Remidio FOP fundus camera.
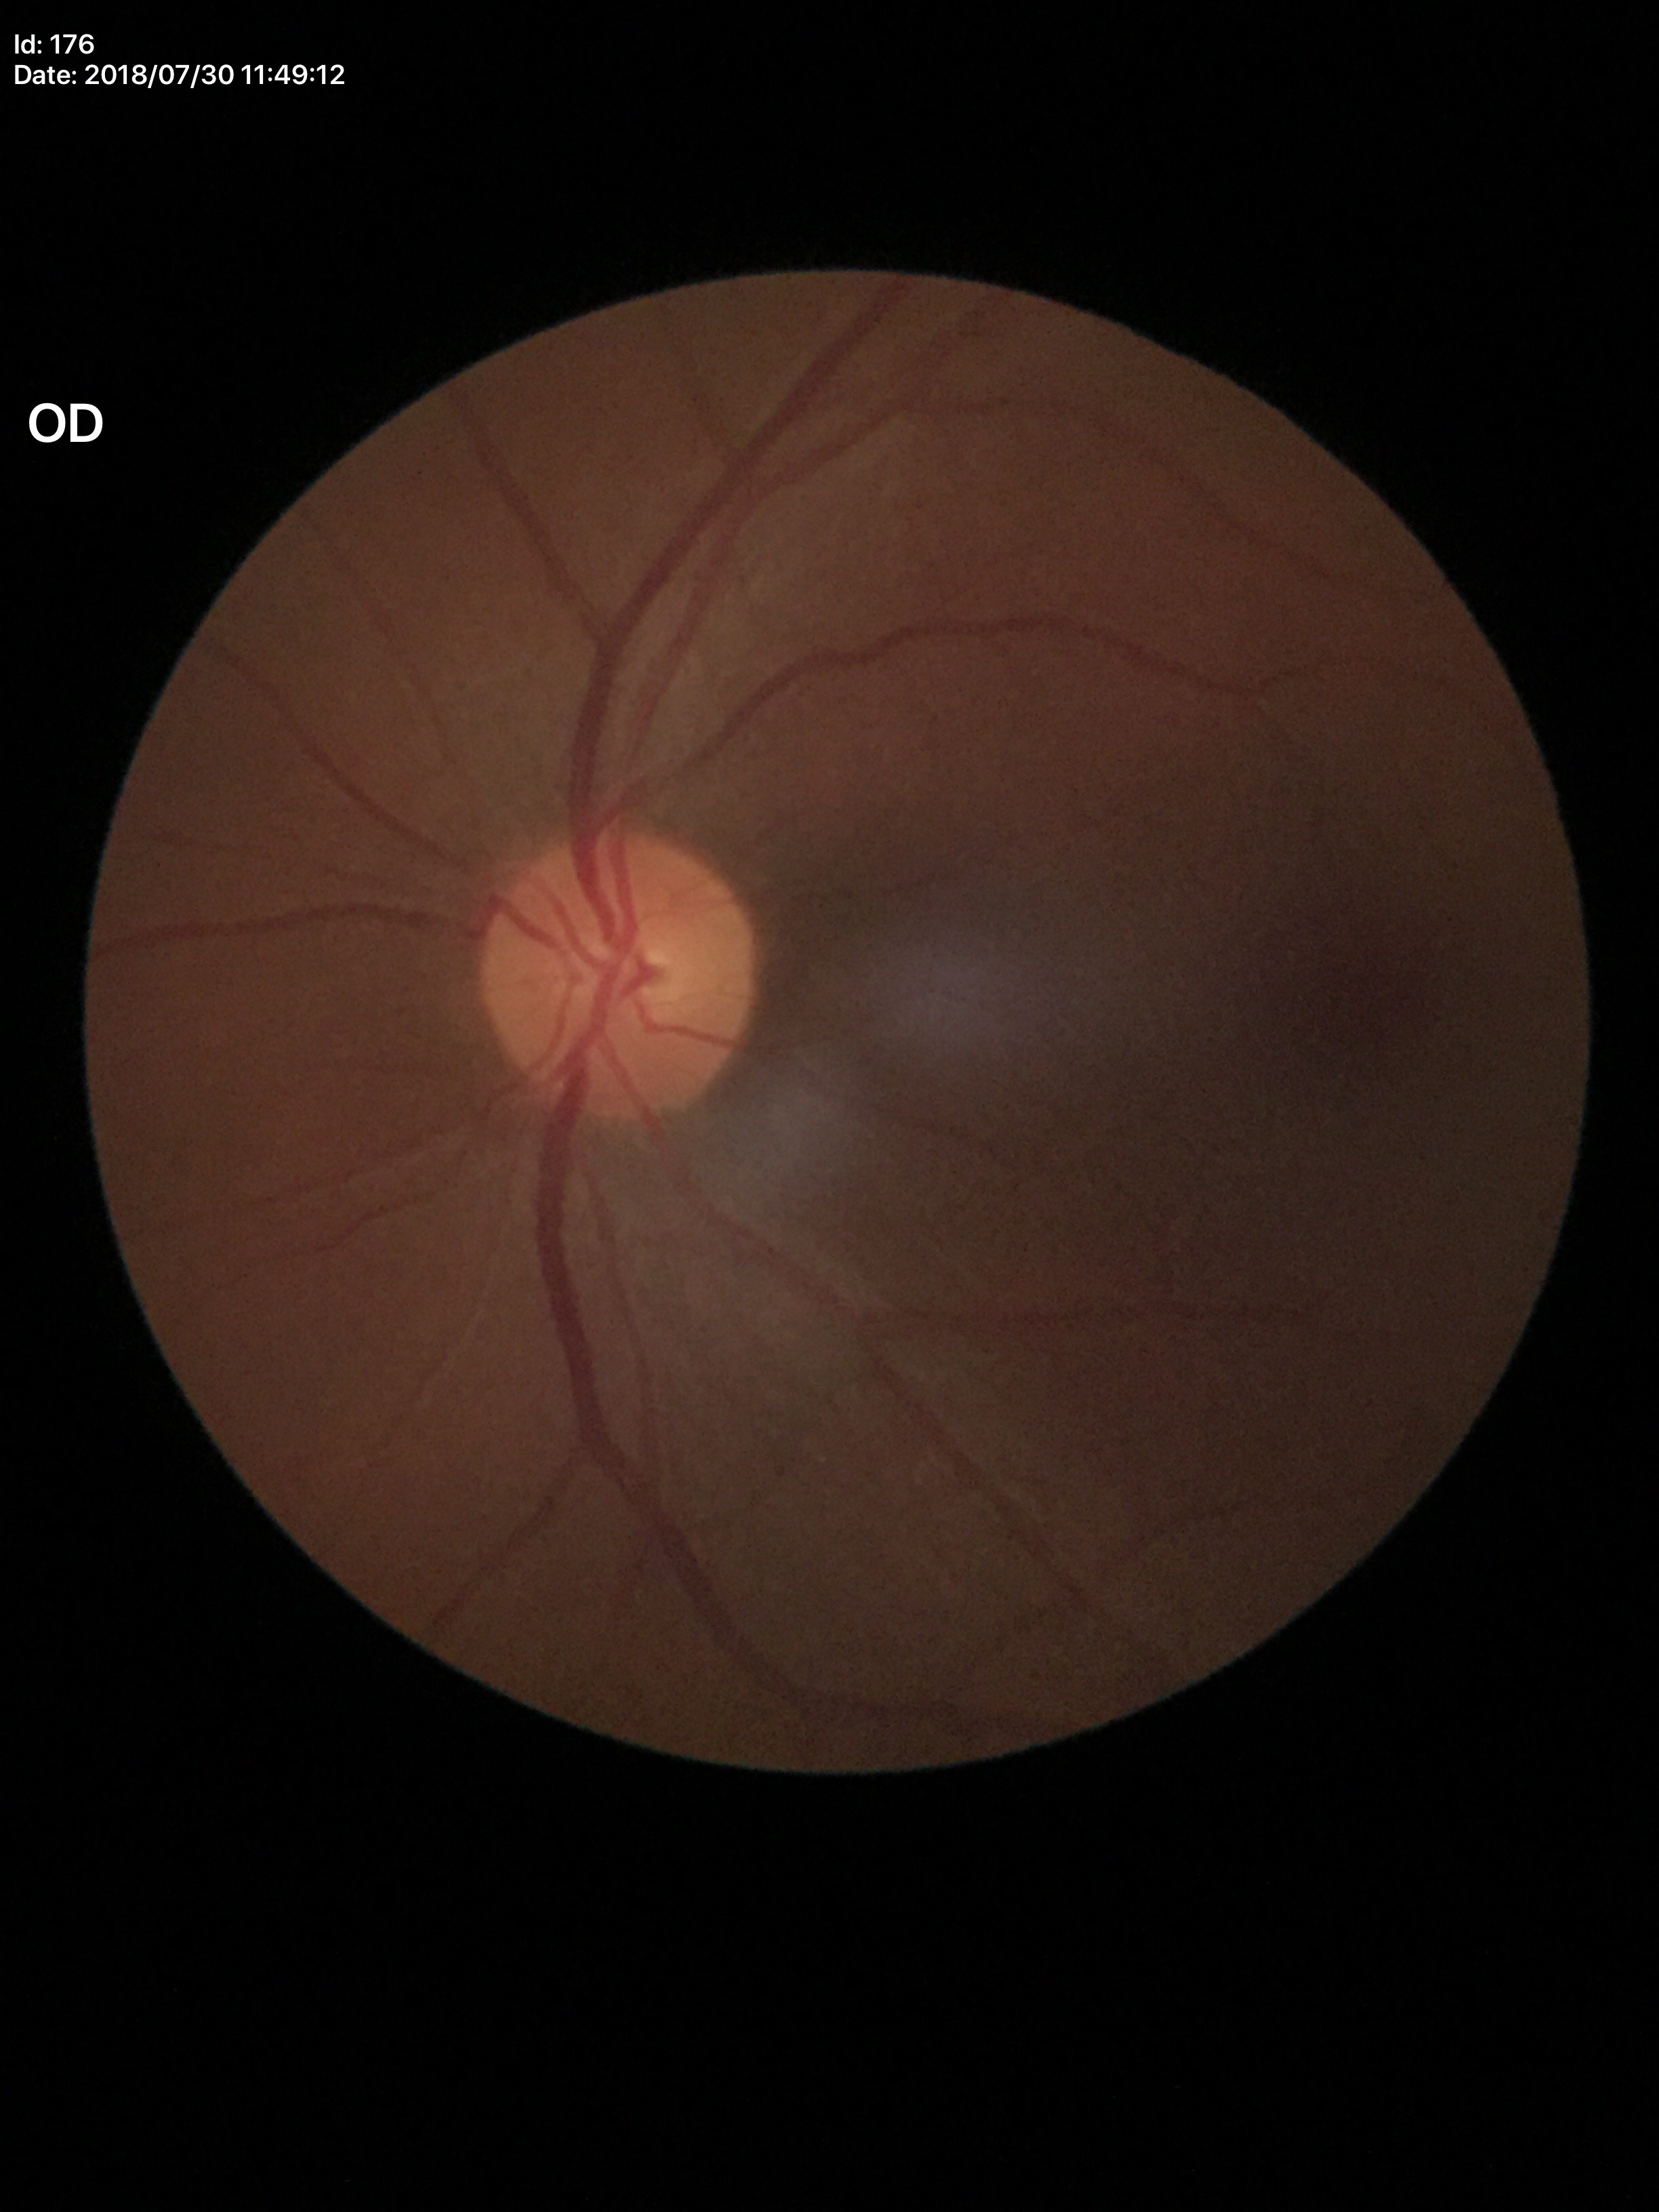
Glaucoma decision = no suspicious findings (all 5 graders called normal), vertical CDR = 0.43.